Nonmydriatic fundus photograph, graded on the modified Davis scale:
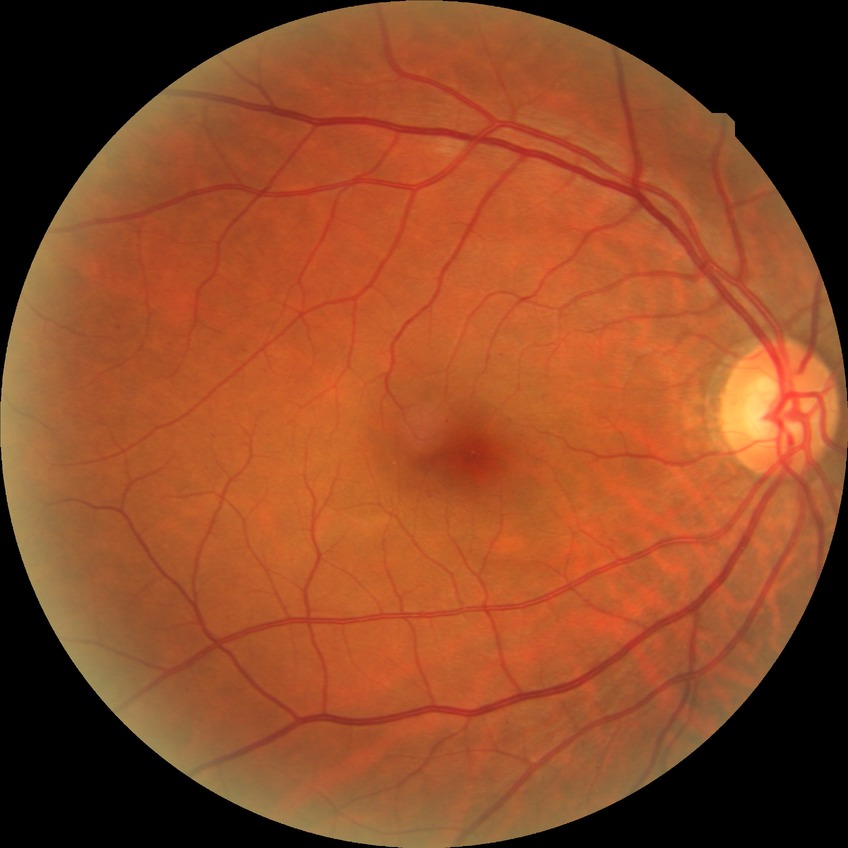 {
  "davis_grade": "simple diabetic retinopathy",
  "proliferative_class": "non-proliferative diabetic retinopathy"
}